Captured after pupil dilation · Topcon TRC-50DX · central posterior field · color fundus photograph.
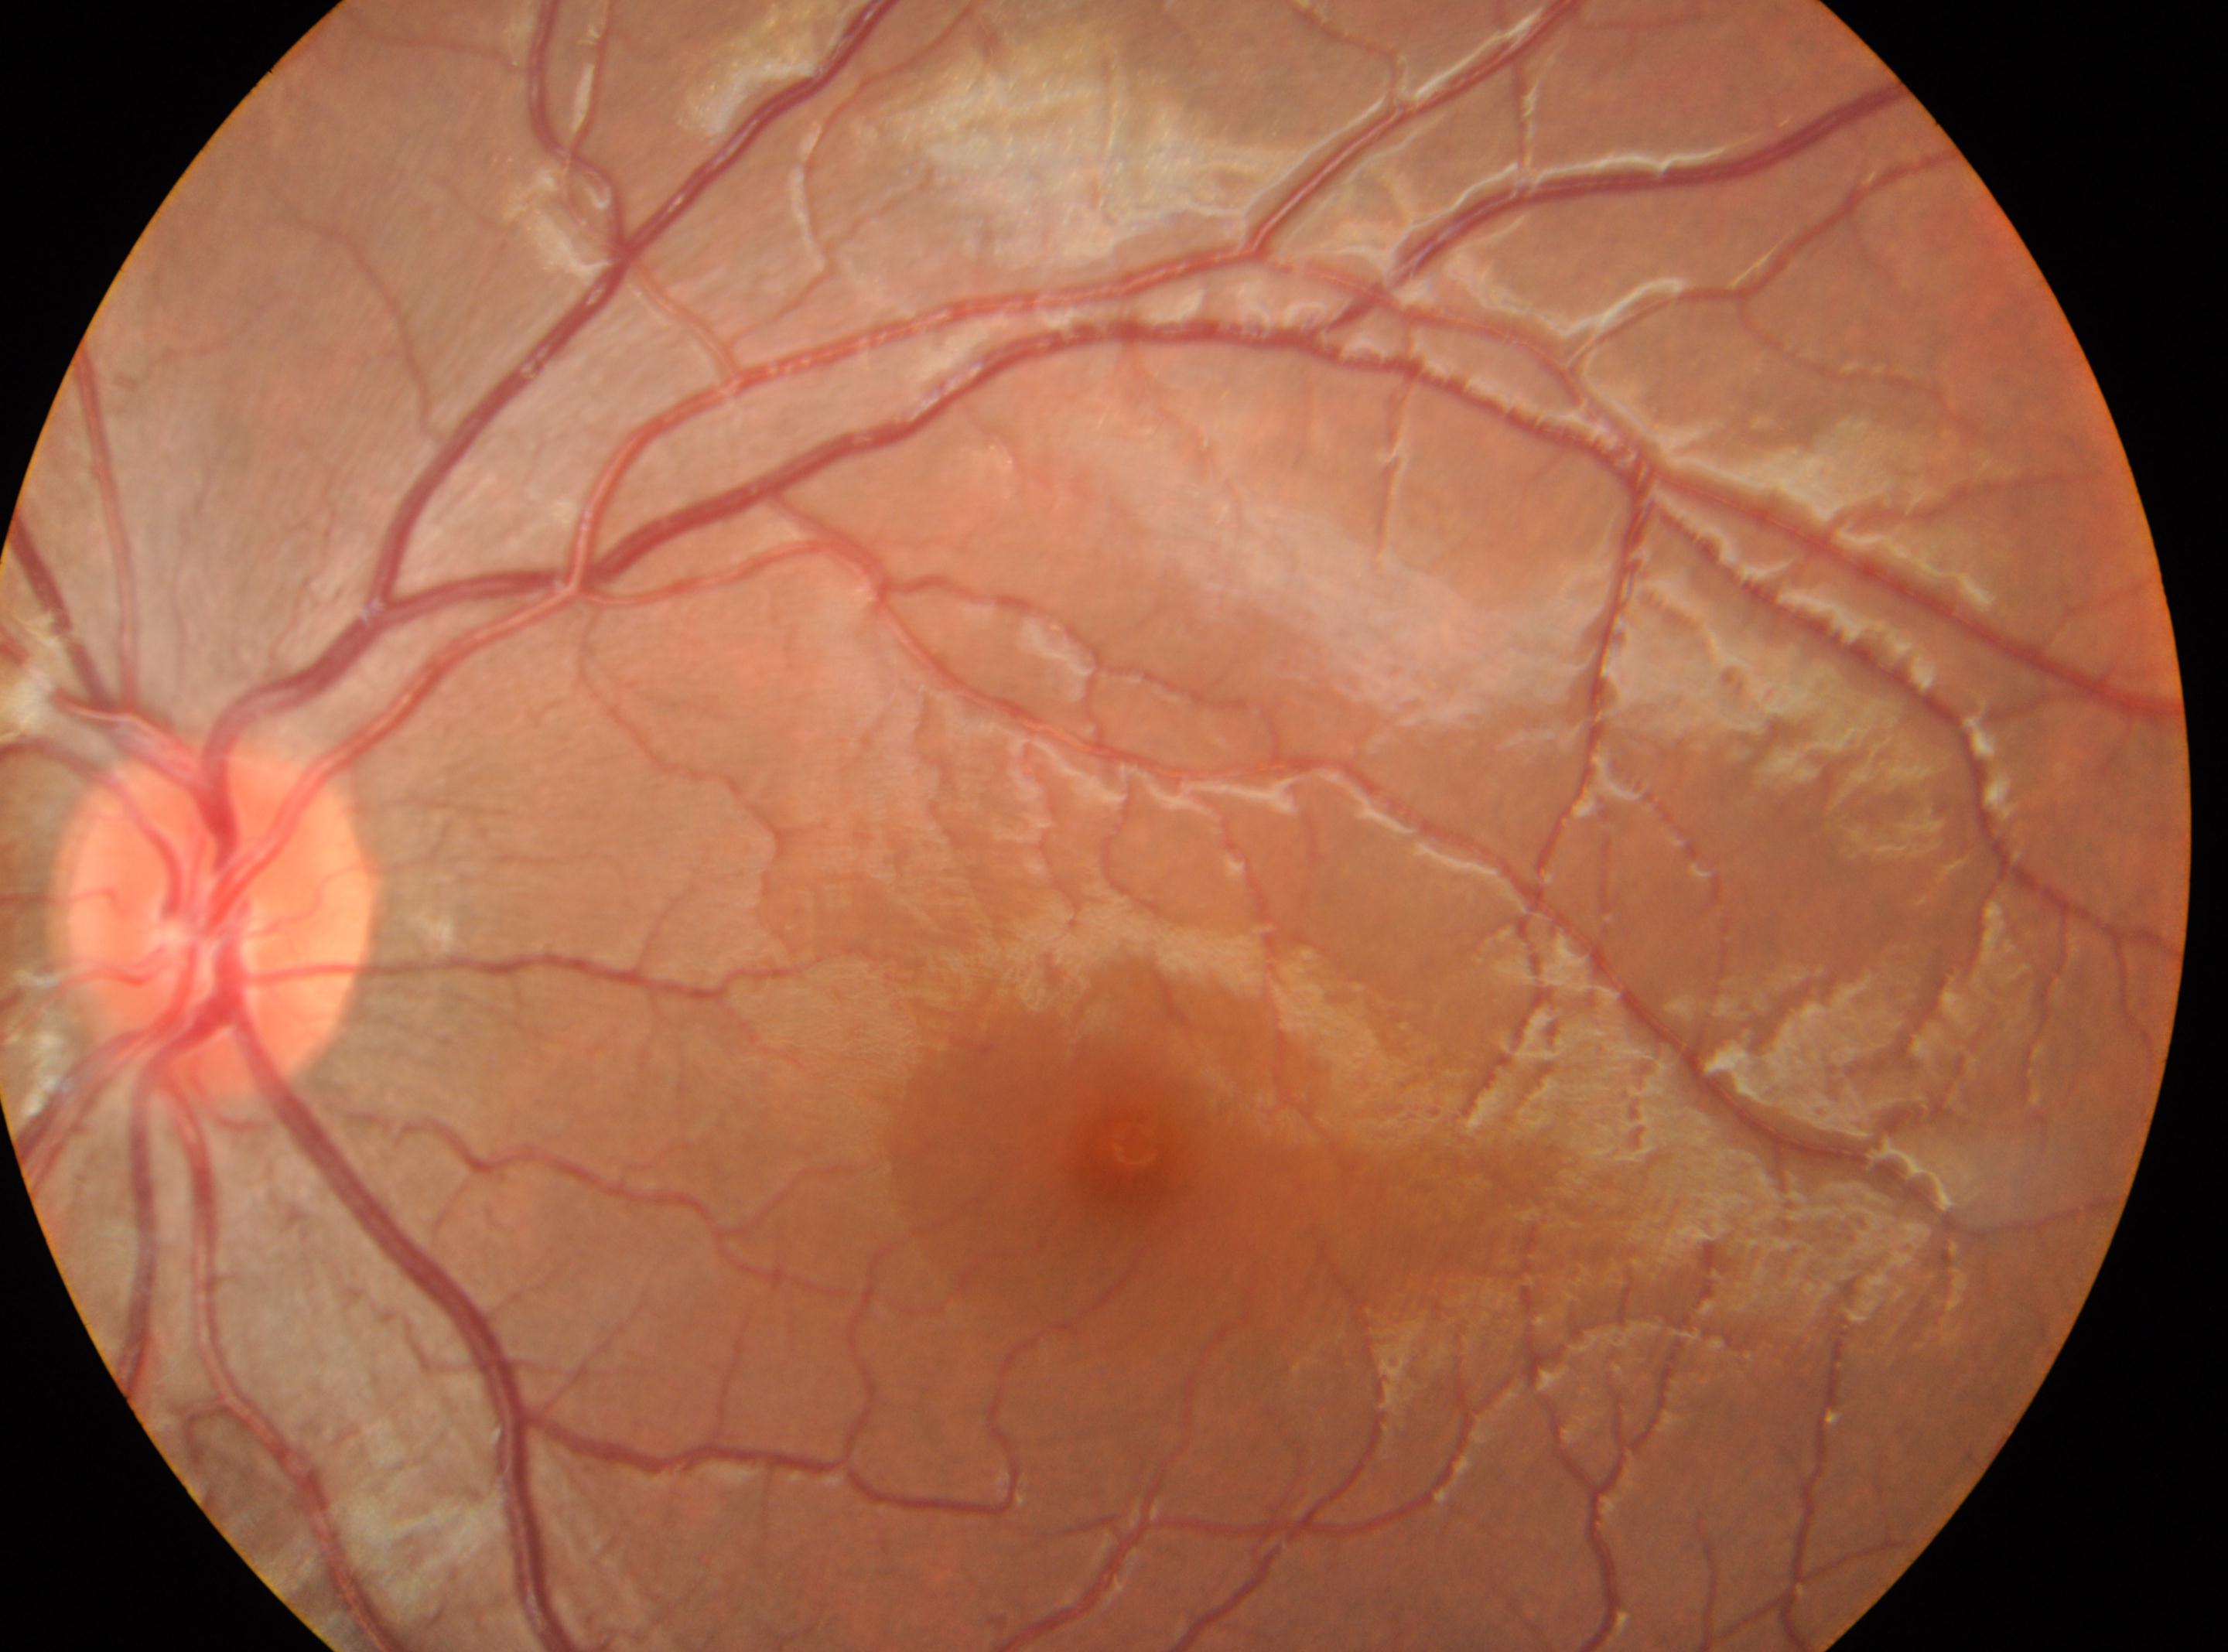

The foveal center is at x=1129, y=1140.
The optic disc center is at x=214, y=920.
Diabetic retinopathy severity: grade 0.
Imaged eye: left.
No diabetic retinopathy identified.